45° field of view, color fundus image, 848 by 848 pixels:
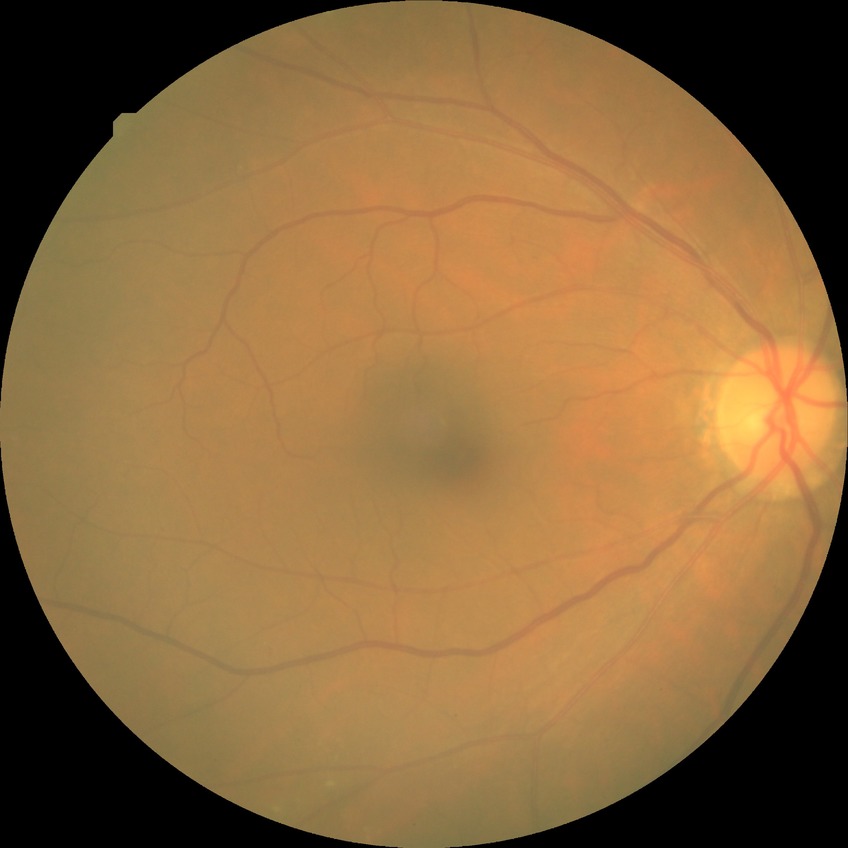
No DR findings. DR severity is NDR.